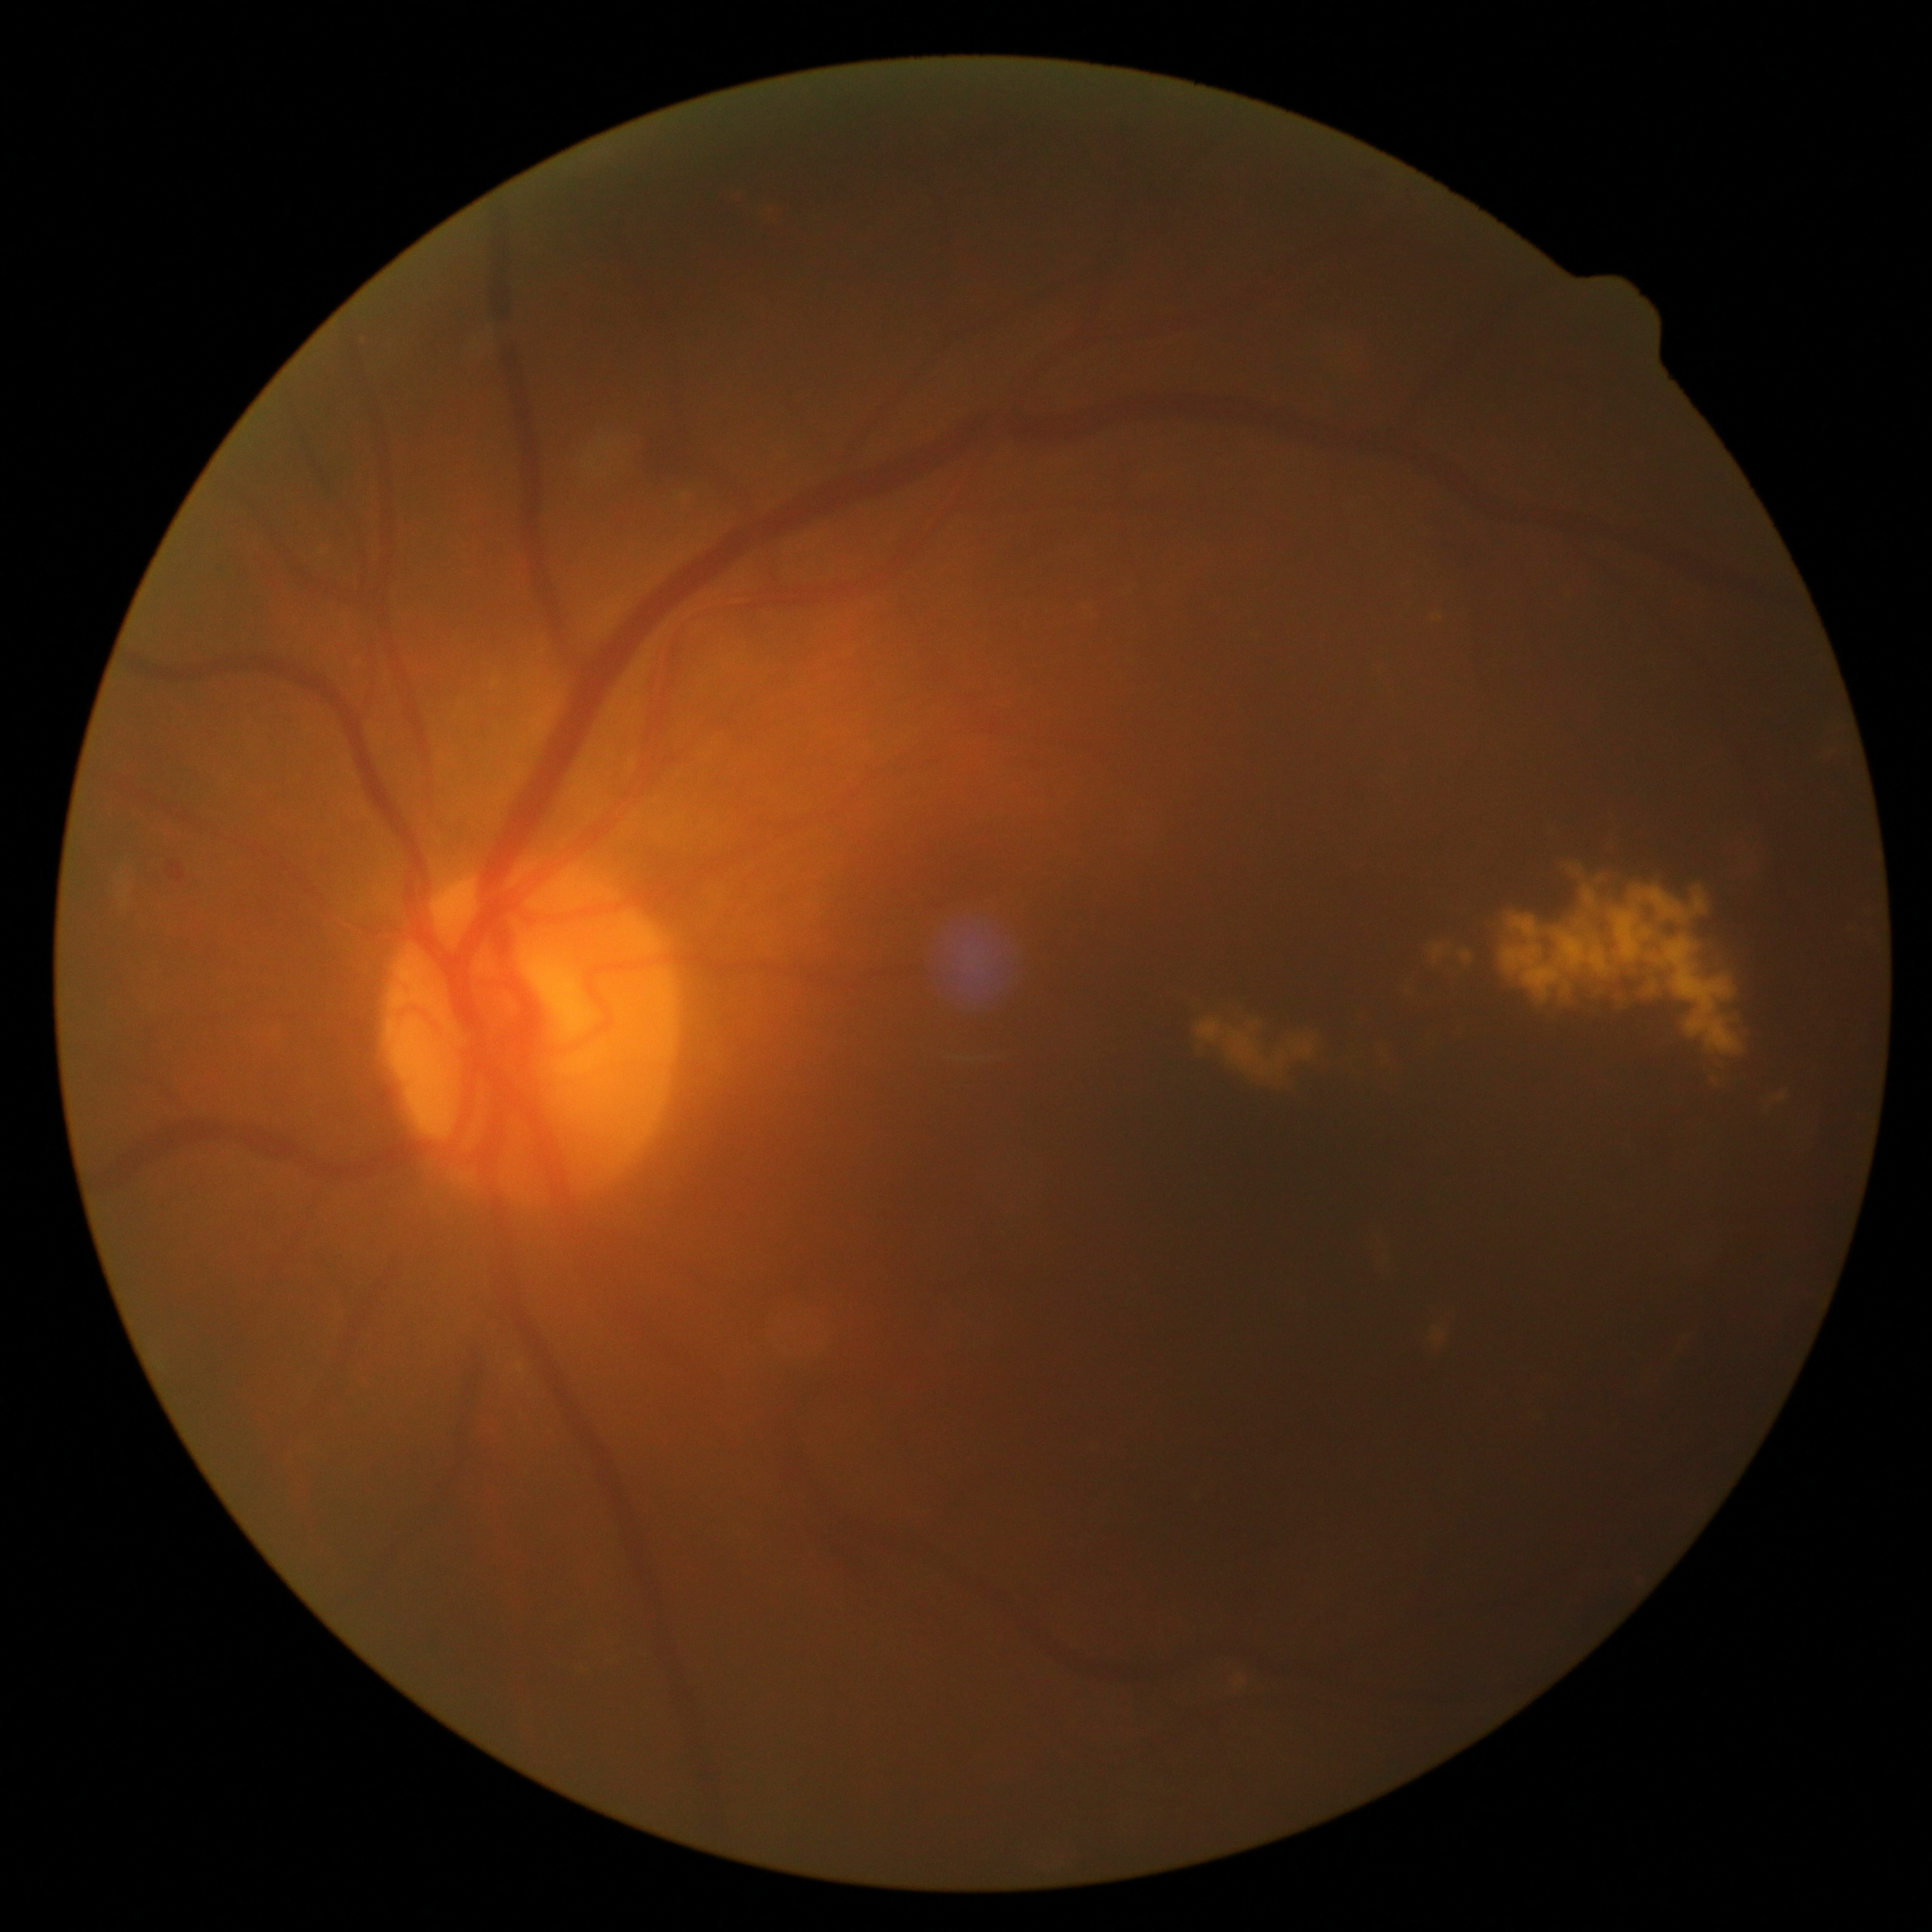

DR severity is 2/4.